1924x1556. CFP: 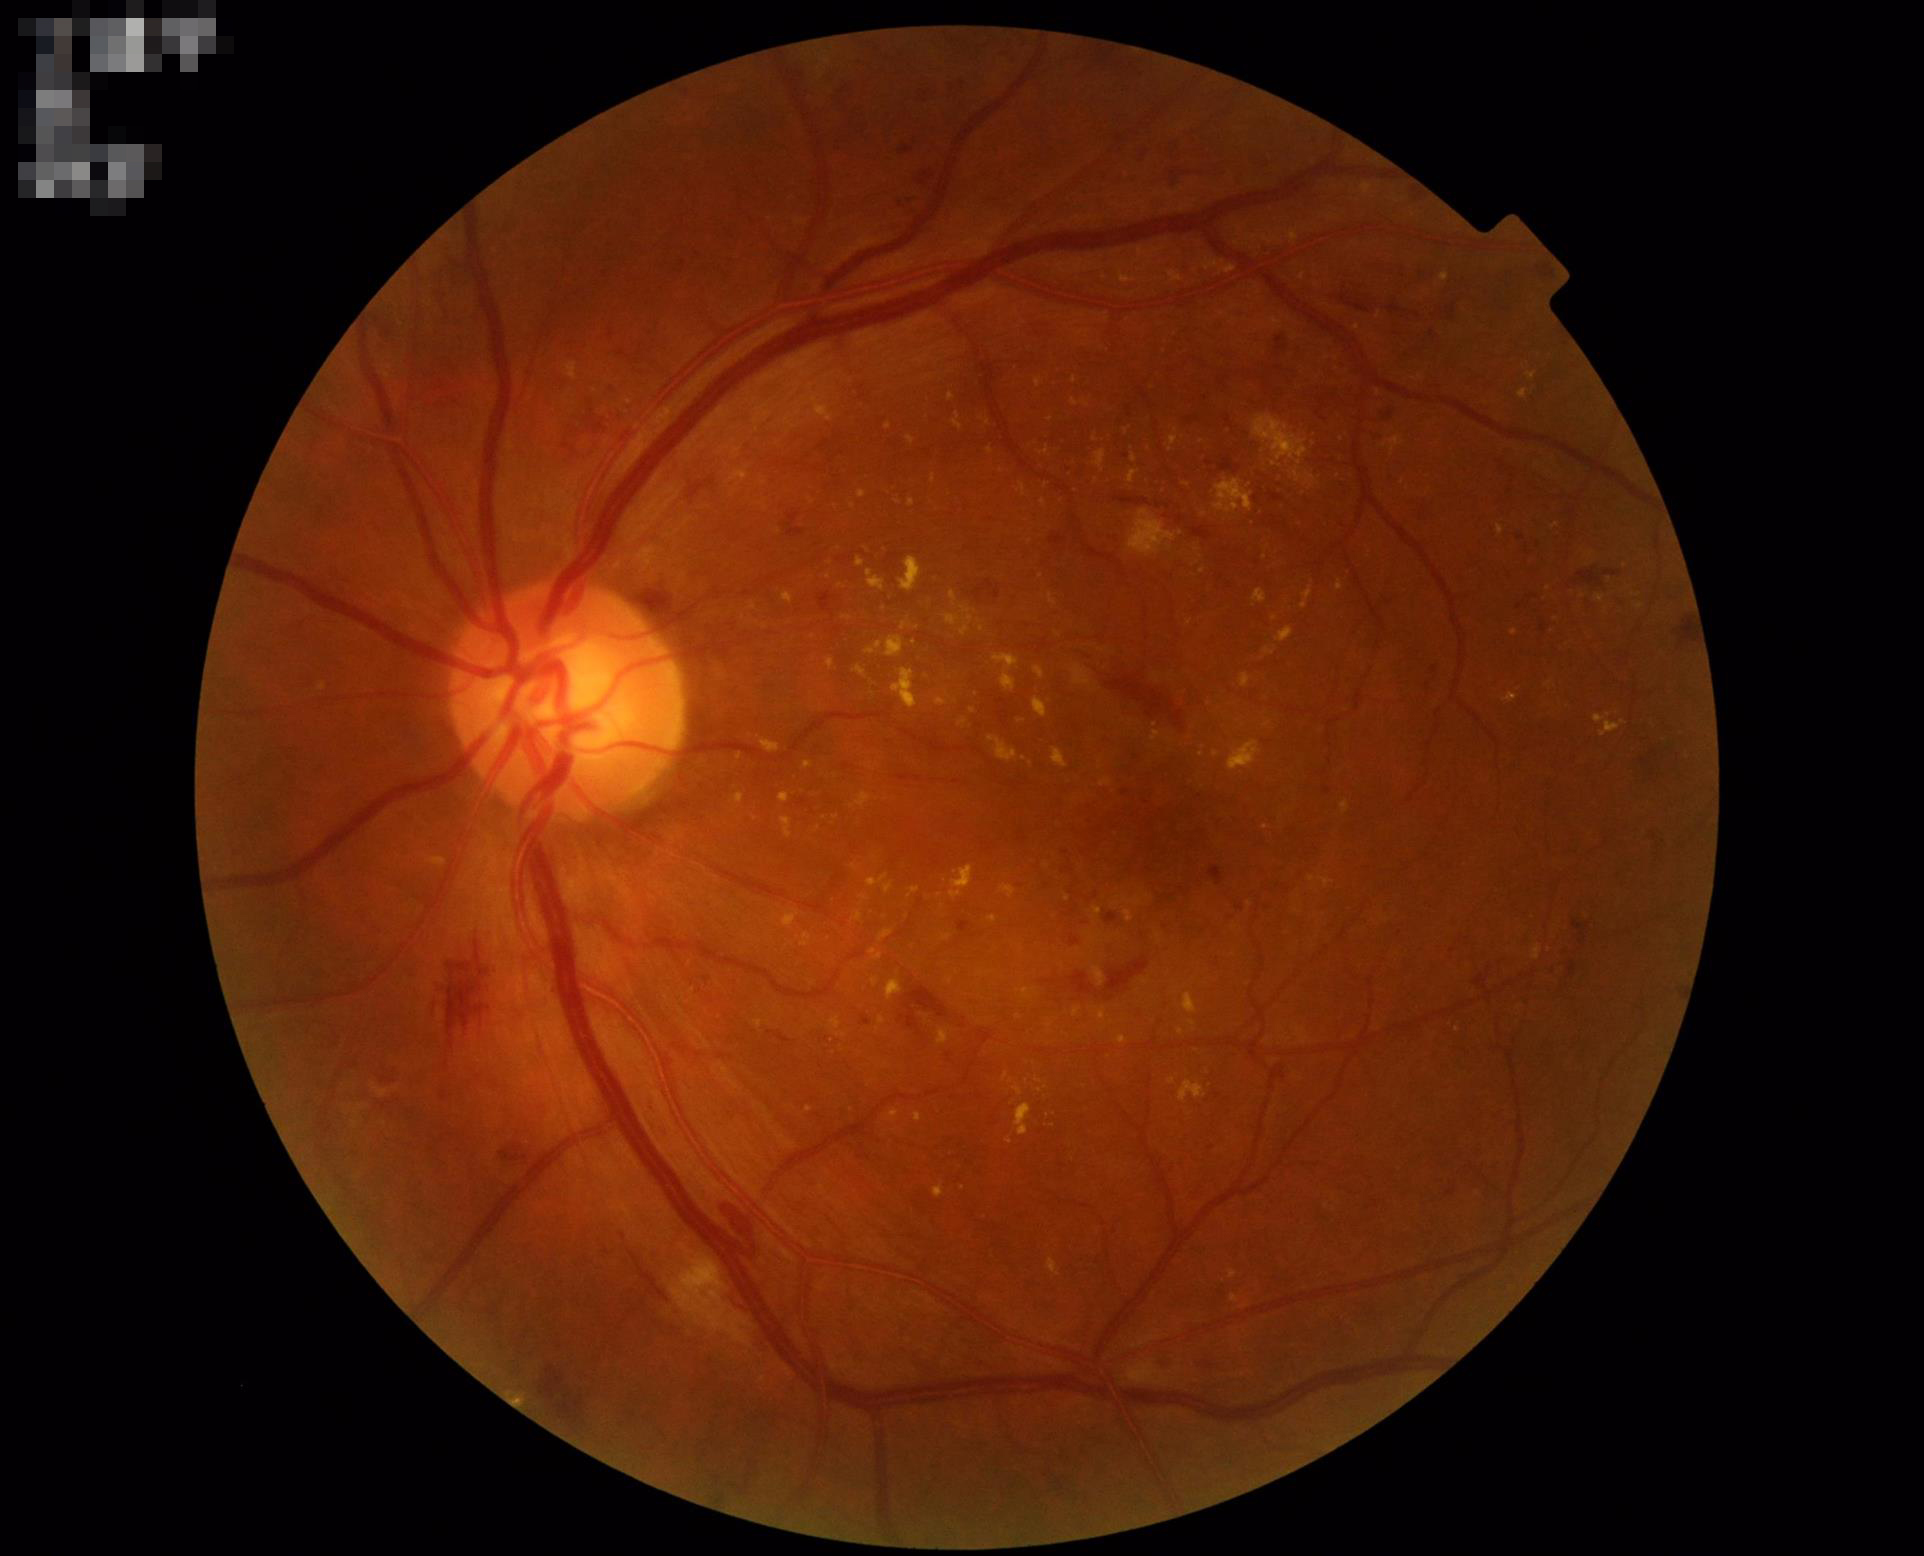 contrast: adequate
clarity: good
overall_quality: good